Diabetic retinopathy graded by the modified Davis classification, NIDEK AFC-230, 45° field of view:
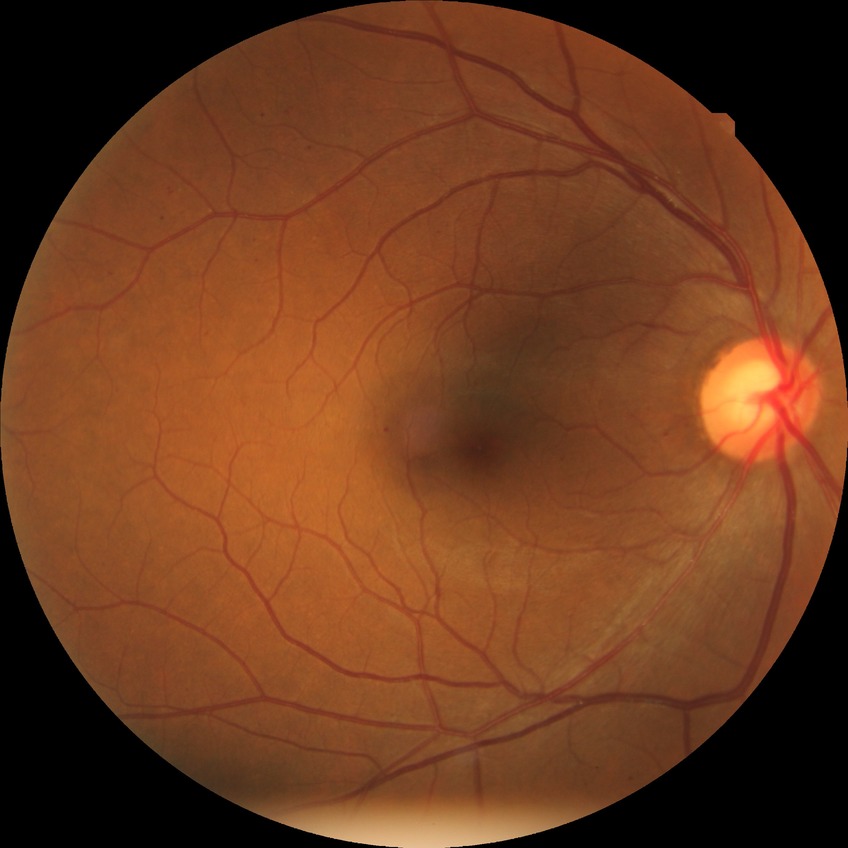 Retinopathy stage: simple diabetic retinopathy.